2352x1568px · retinal fundus photograph:
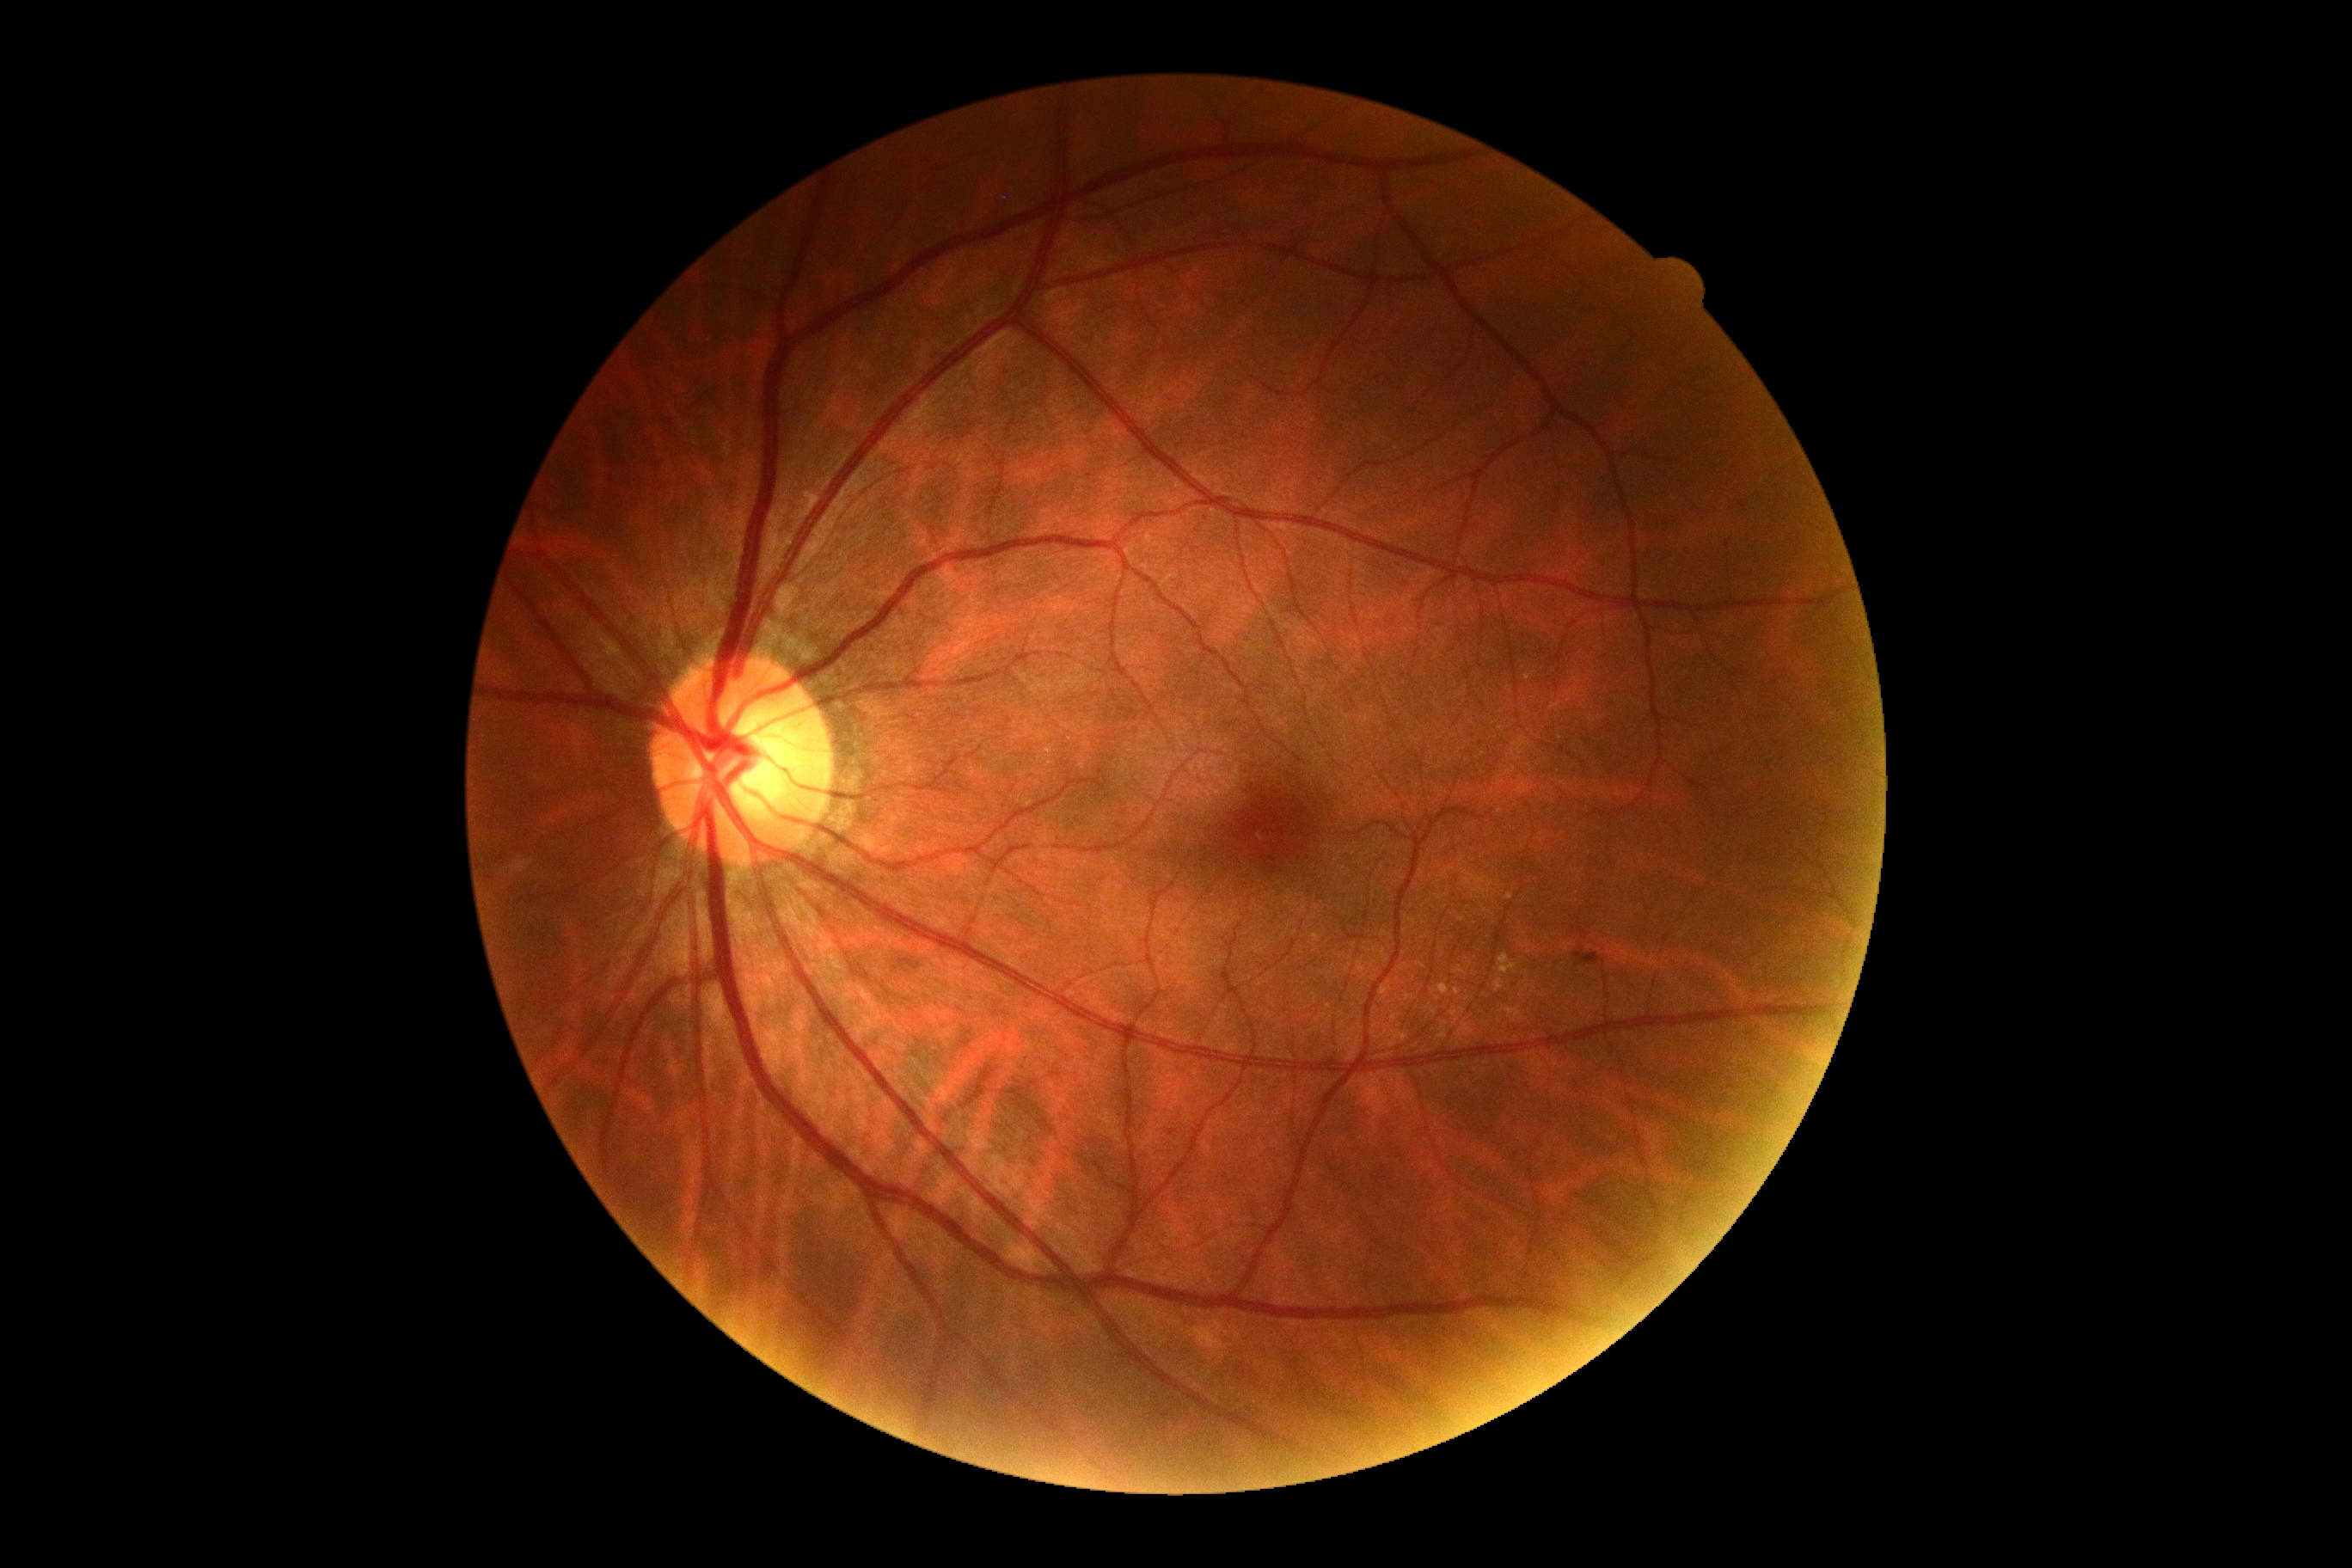

DR severity is 2/4 — more than just microaneurysms but less than severe NPDR
MAs: none detected
HEs: Rect(1574, 946, 1605, 967)
SEs: none detected
EXs: Rect(1498, 953, 1517, 976) | Rect(1493, 979, 1505, 993)